1932 by 1916 pixels; fundus photo; FOV: 45 degrees — 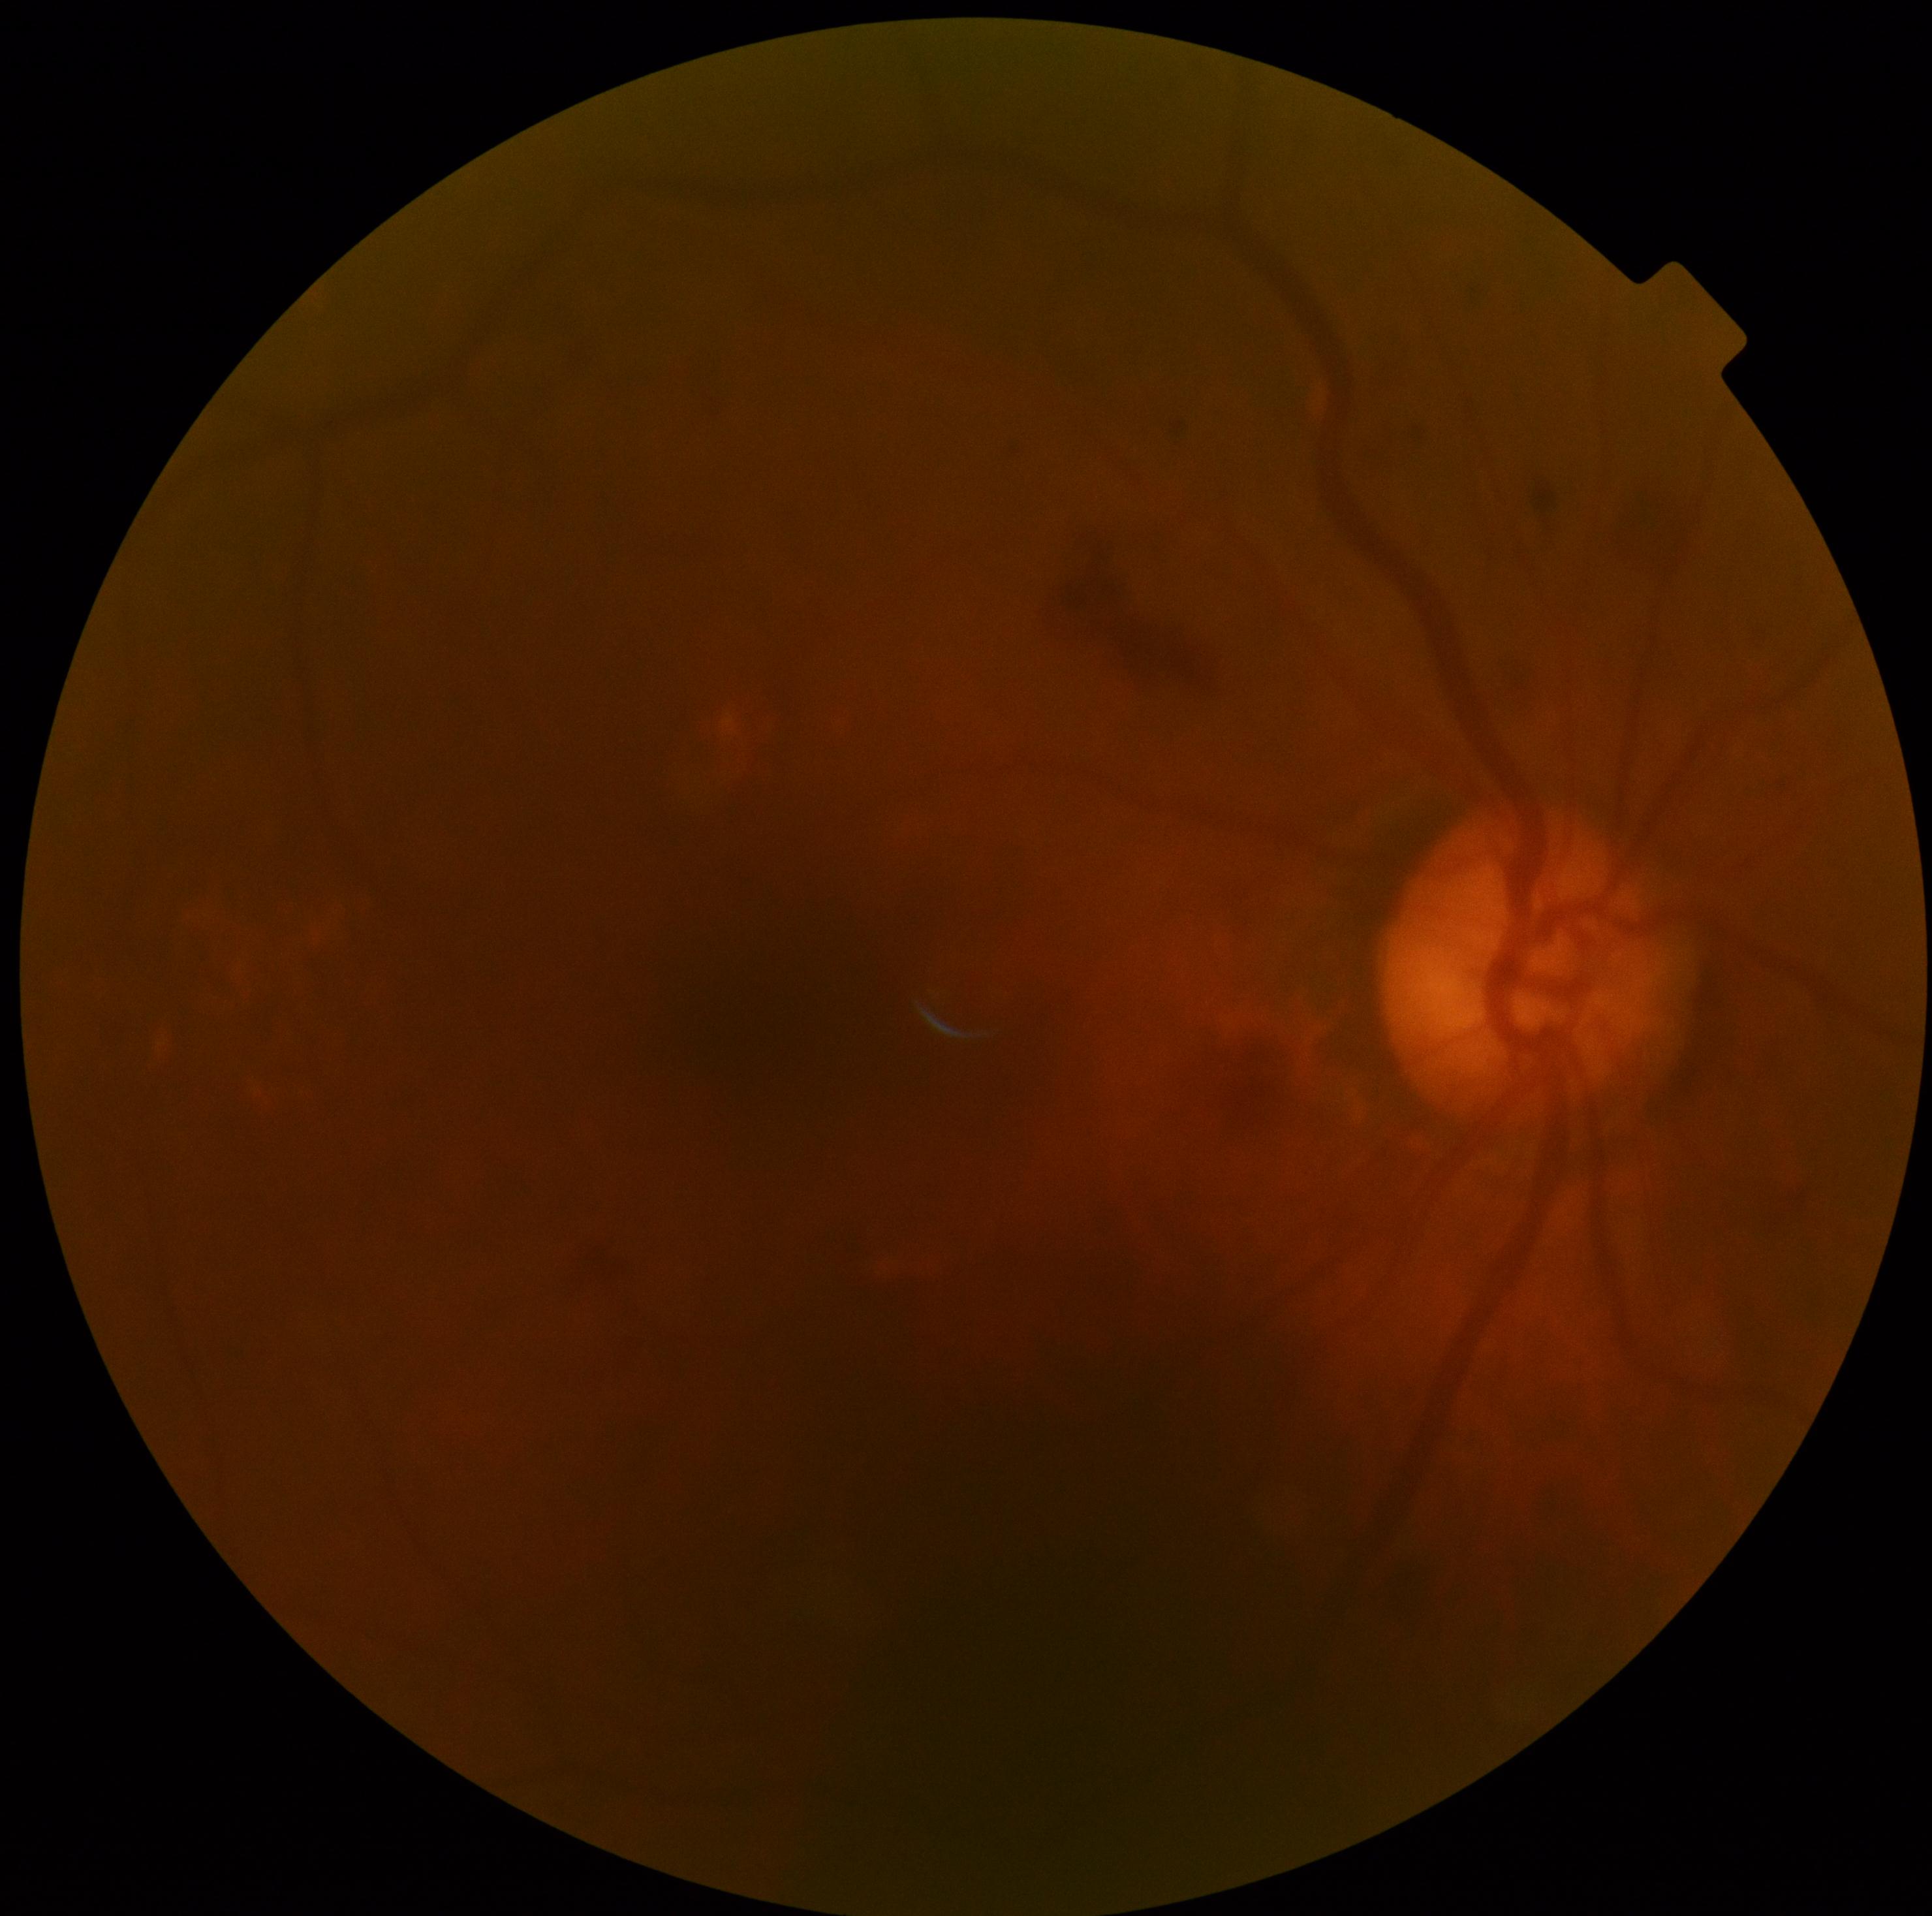 Diabetic retinopathy severity: grade 2.